Color fundus photograph; image size 1932x1932; 45° field of view.
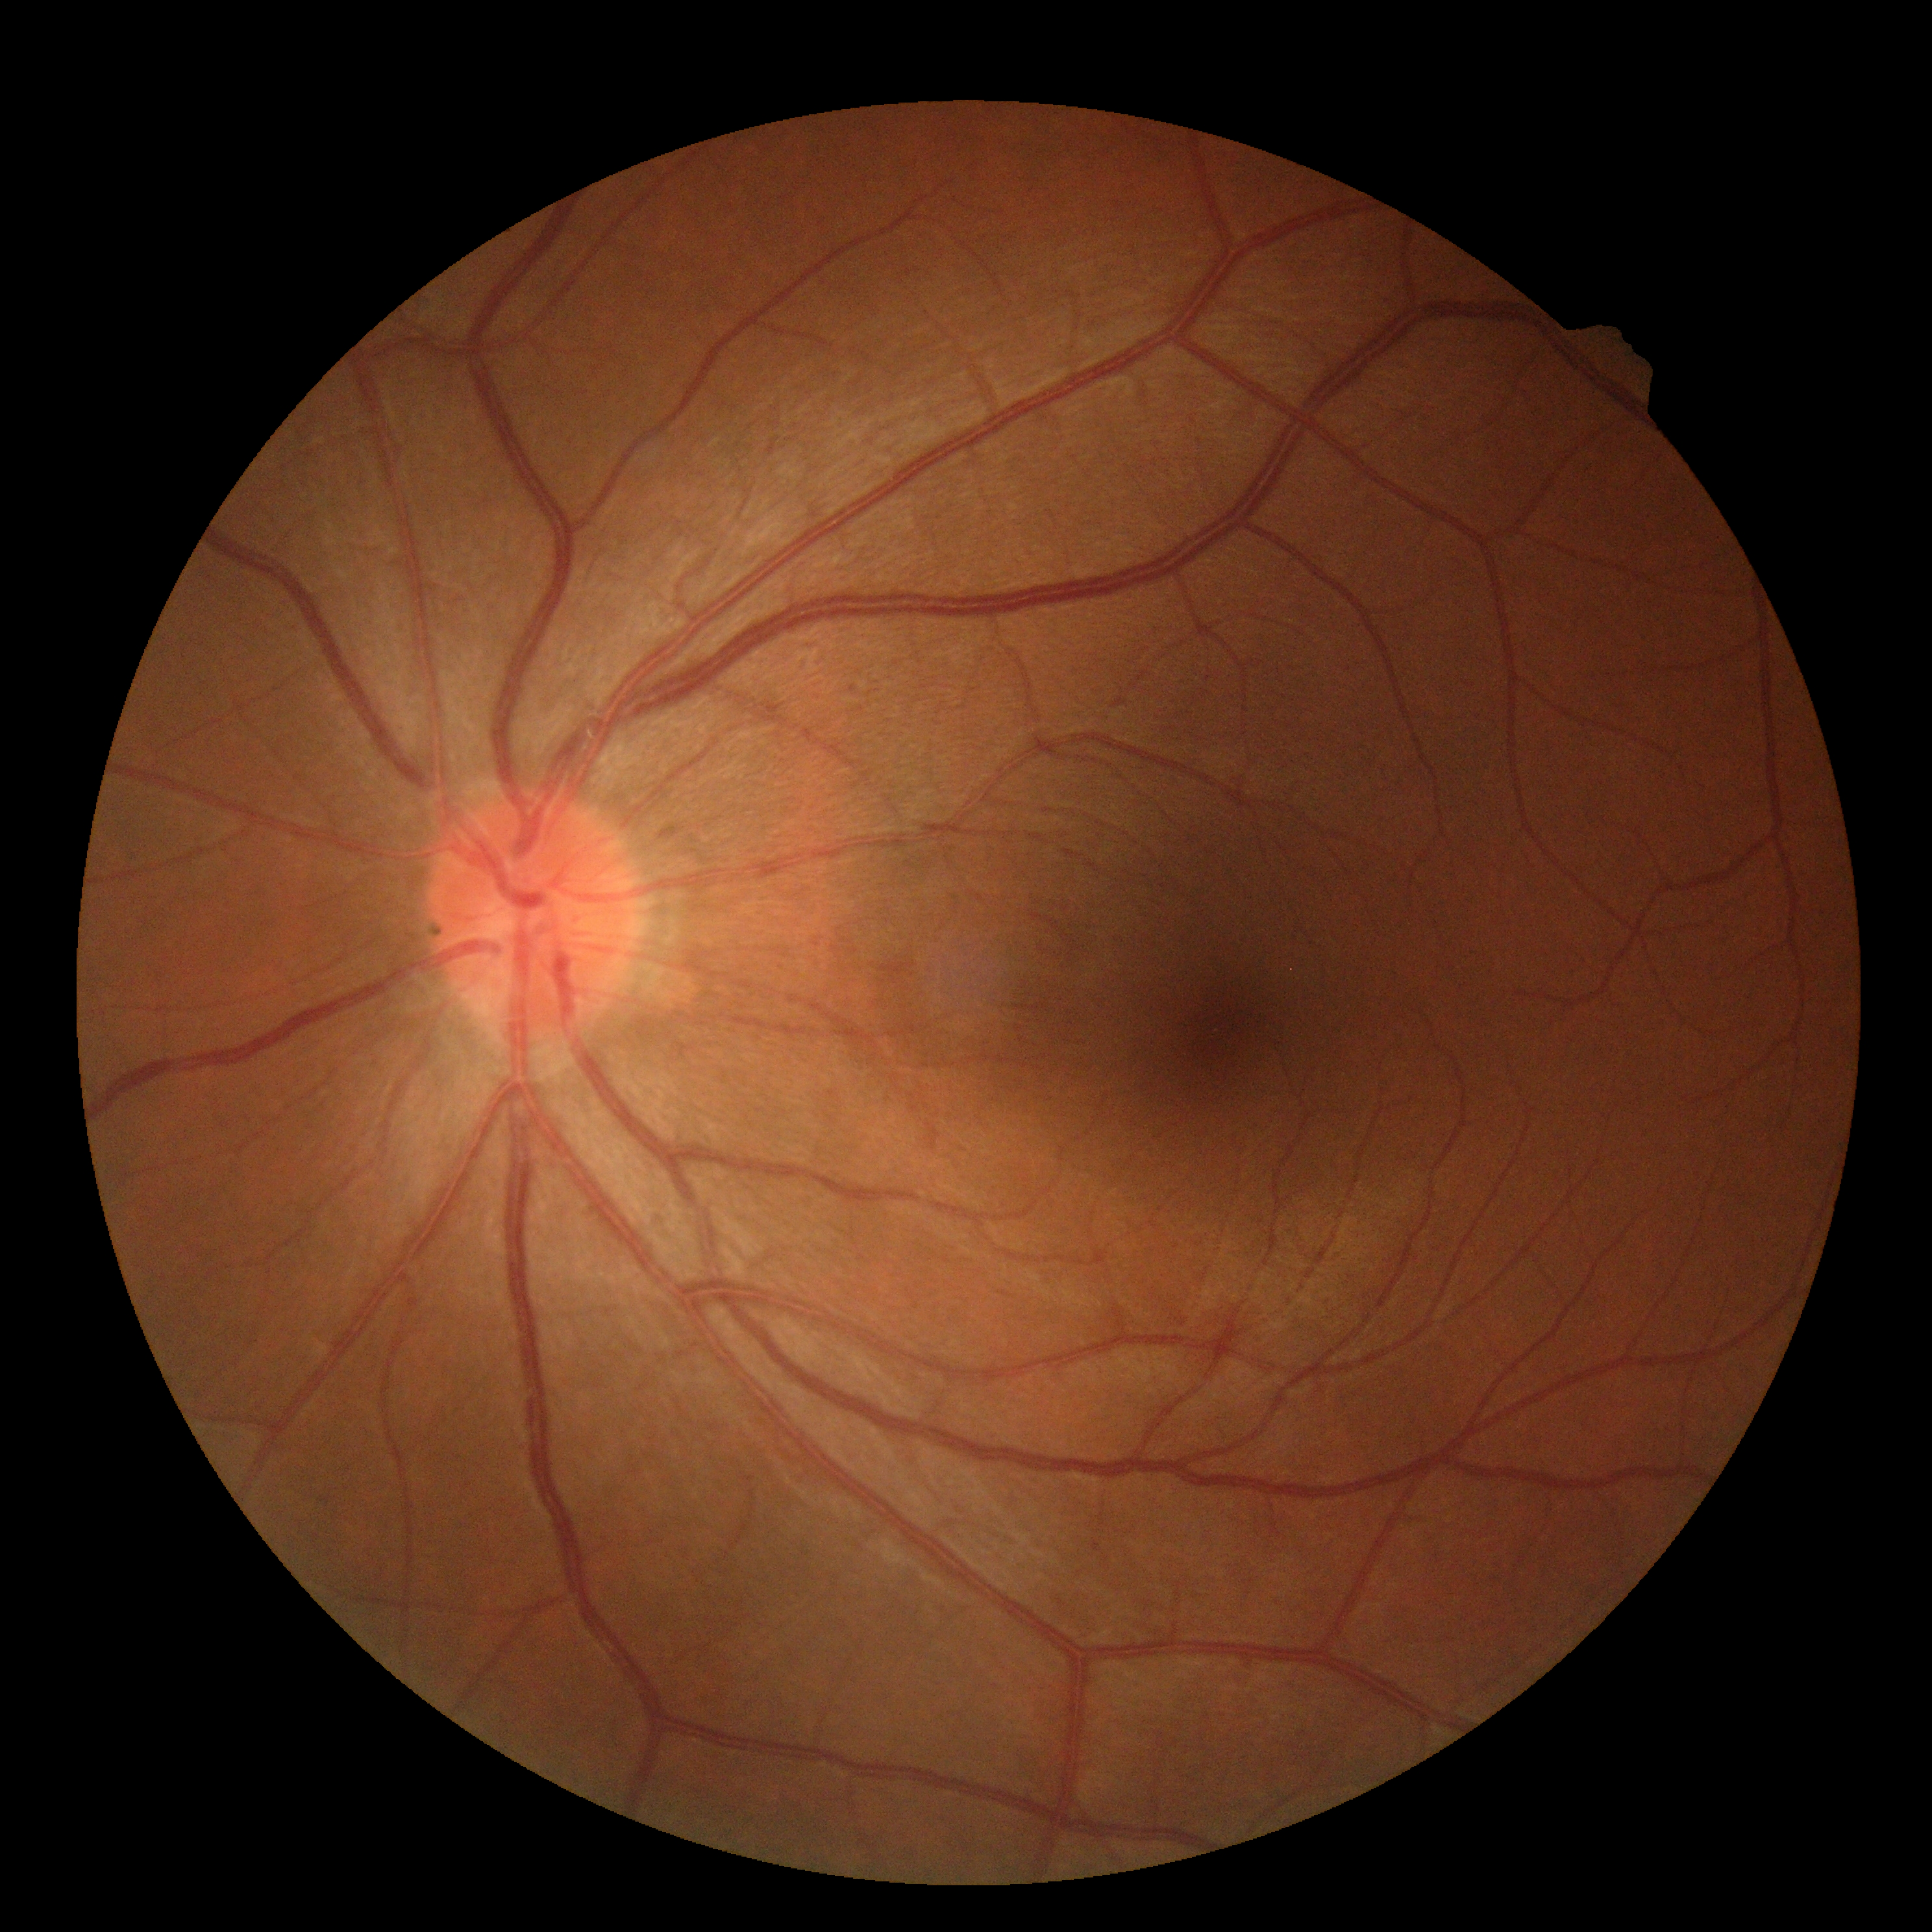 DR stage: grade 0